NIDEK AFC-230 fundus camera; 45 degree fundus photograph; no pharmacologic dilation.
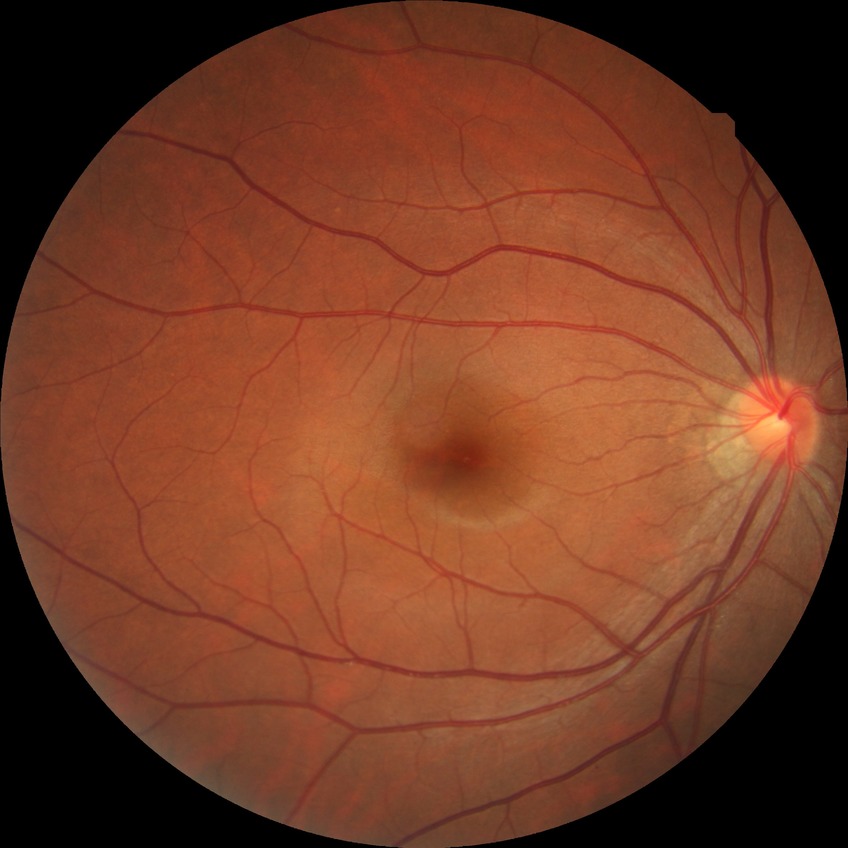 Diabetic retinopathy severity: no diabetic retinopathy.